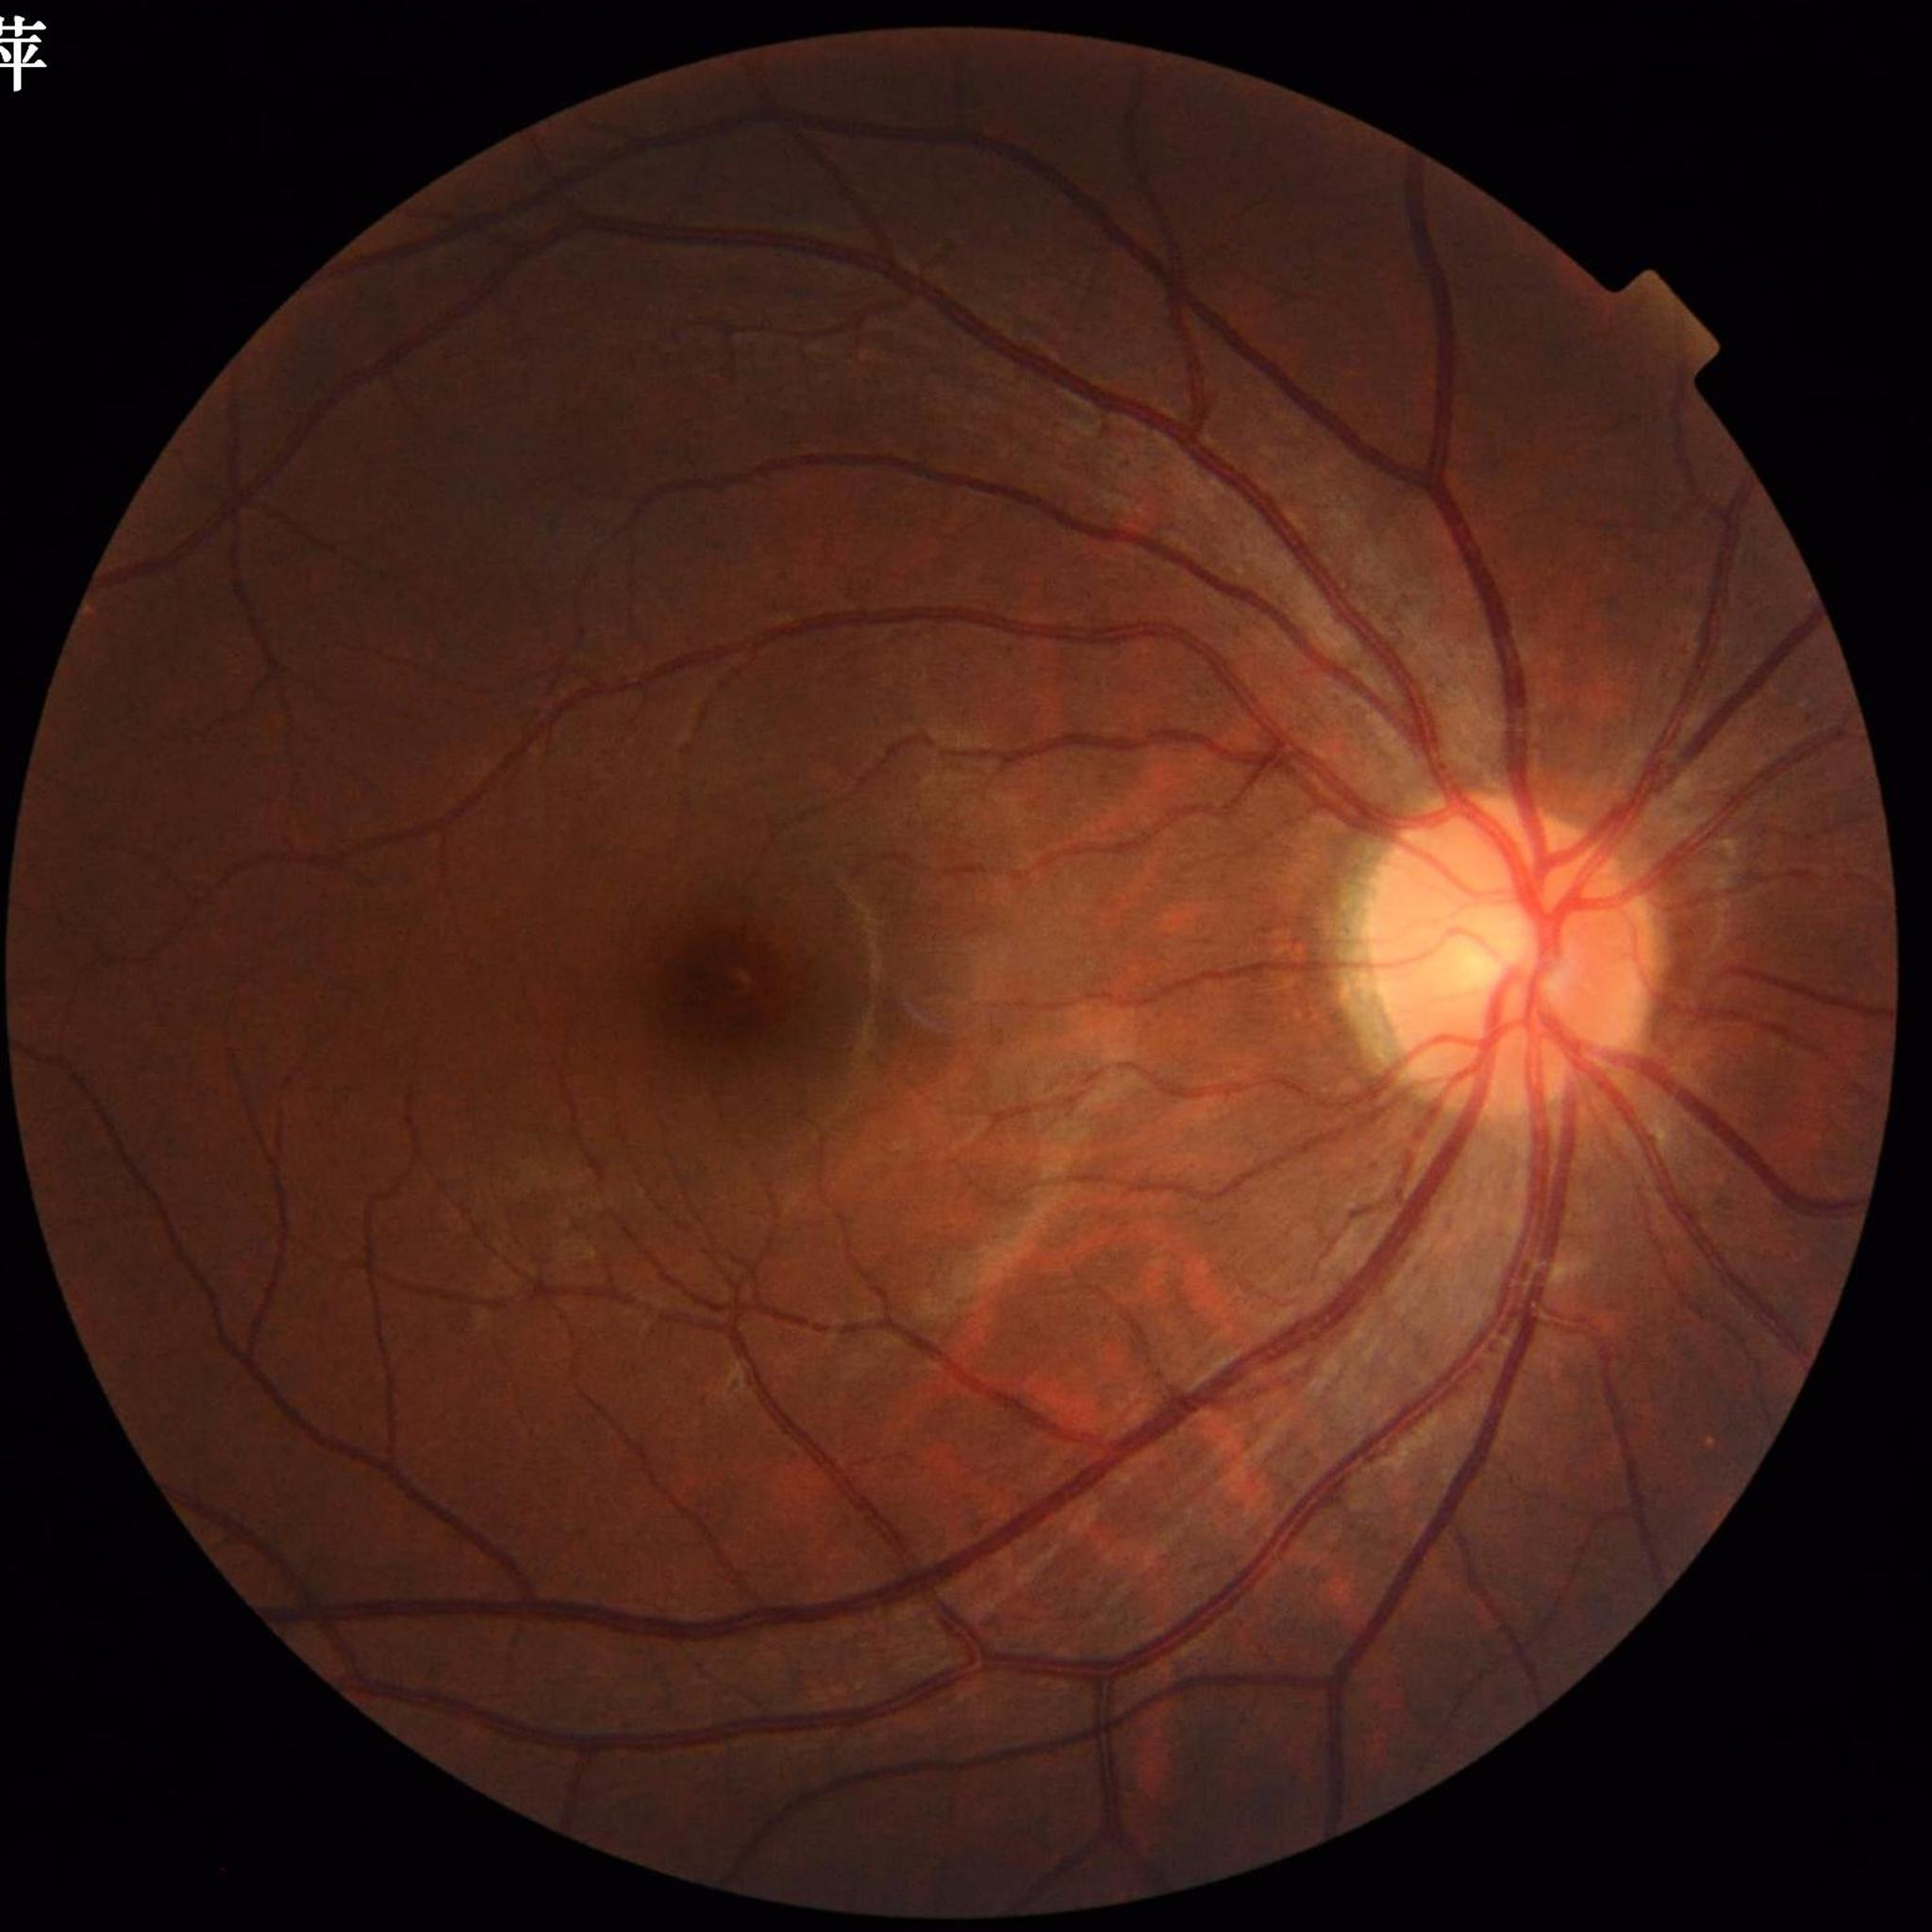 Image quality: no quality issues identified.
Fundus image with no AMD, diabetic retinopathy, or glaucomatous findings.